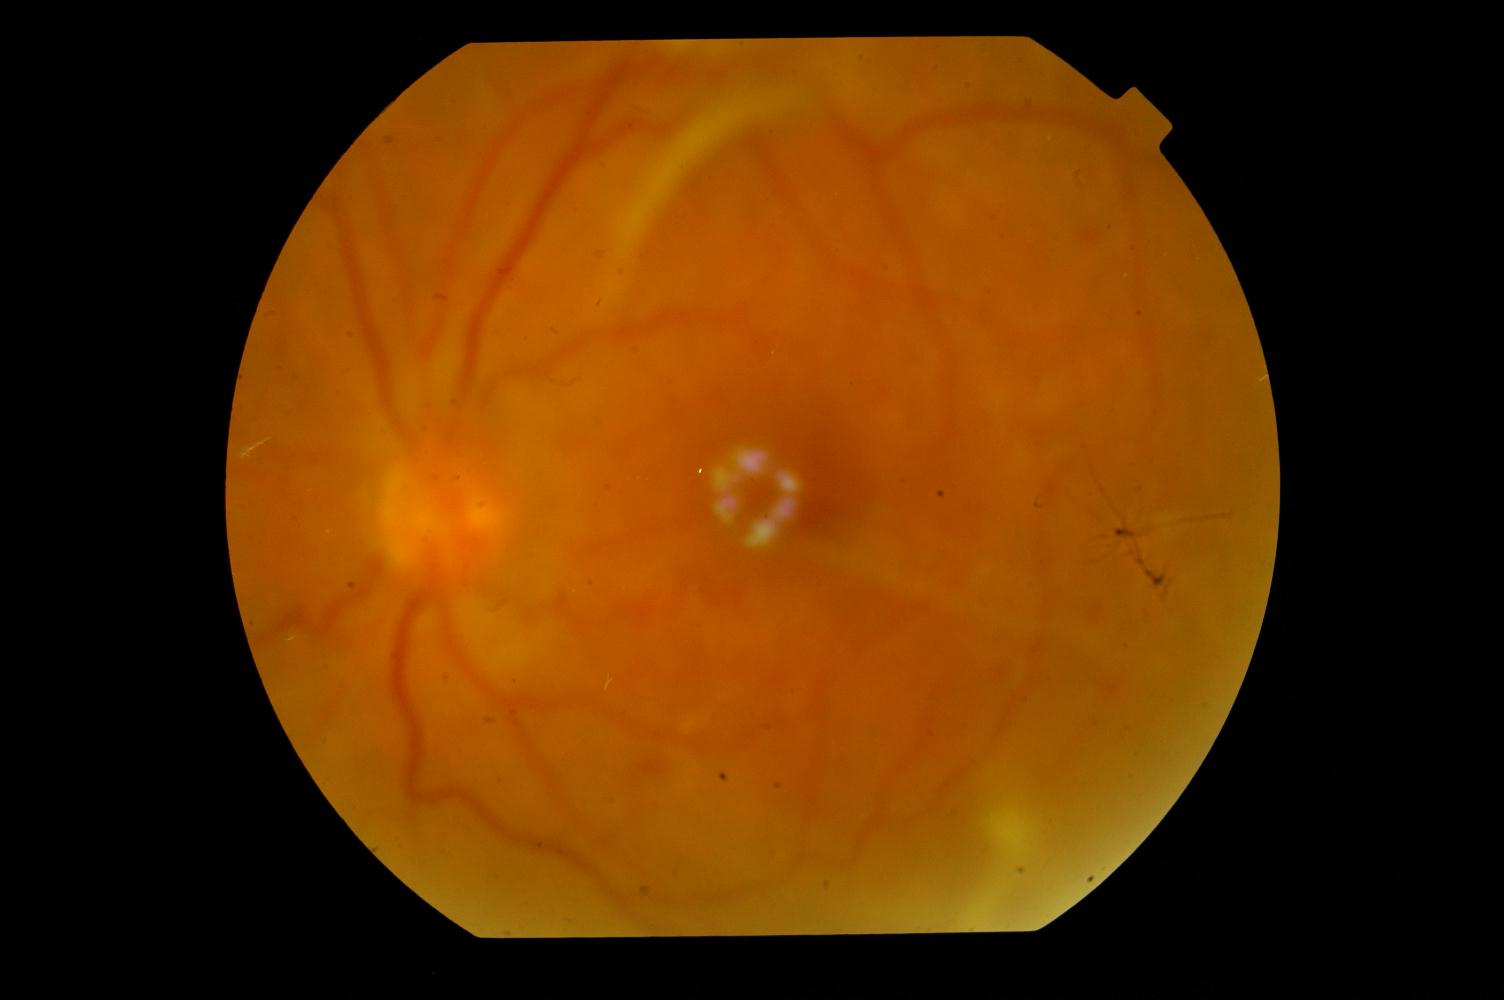
Fundus appearance consistent with diabetic retinopathy.